Modified Davis classification:
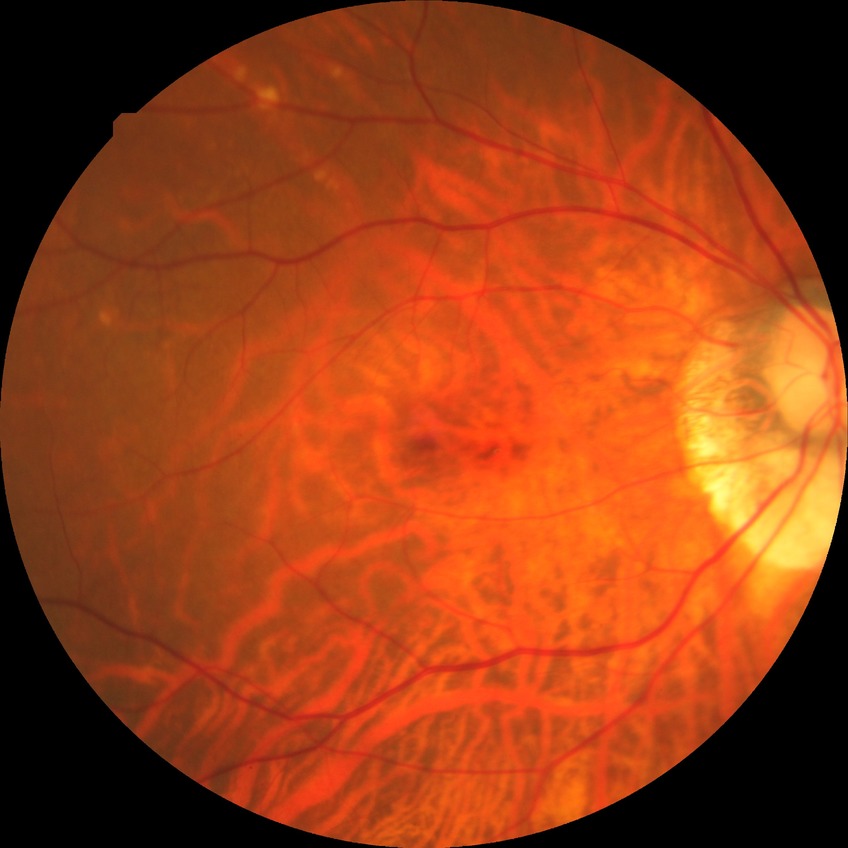 diabetic retinopathy (DR): no diabetic retinopathy (NDR).